Graded on the modified Davis scale: 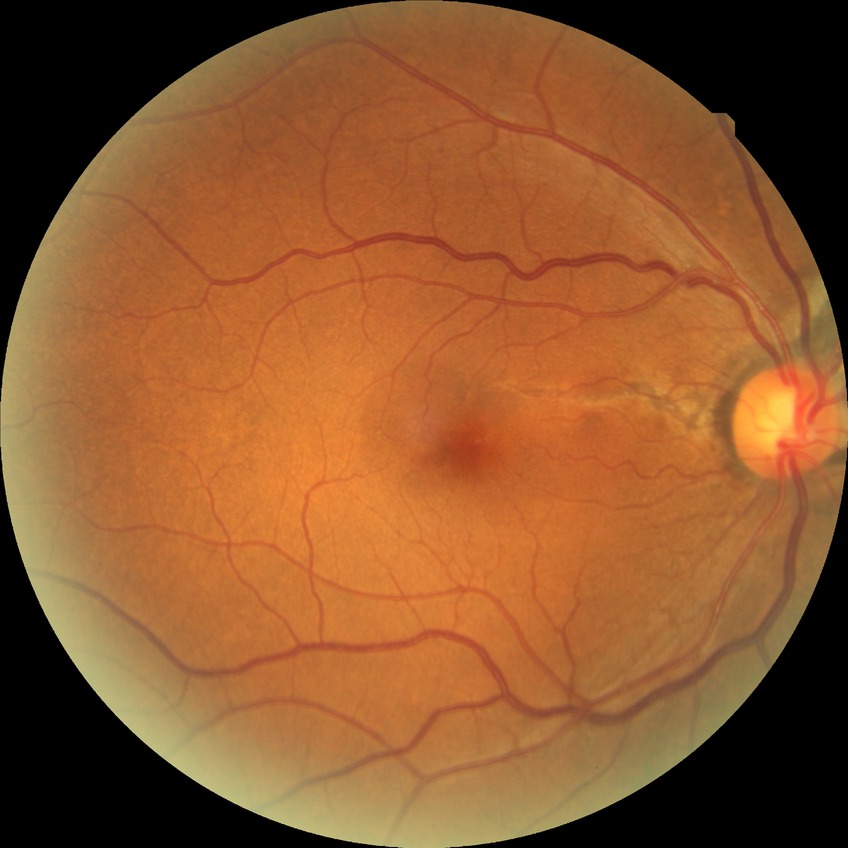 Diabetic retinopathy (DR): NDR (no diabetic retinopathy).